2352 by 1568 pixels.
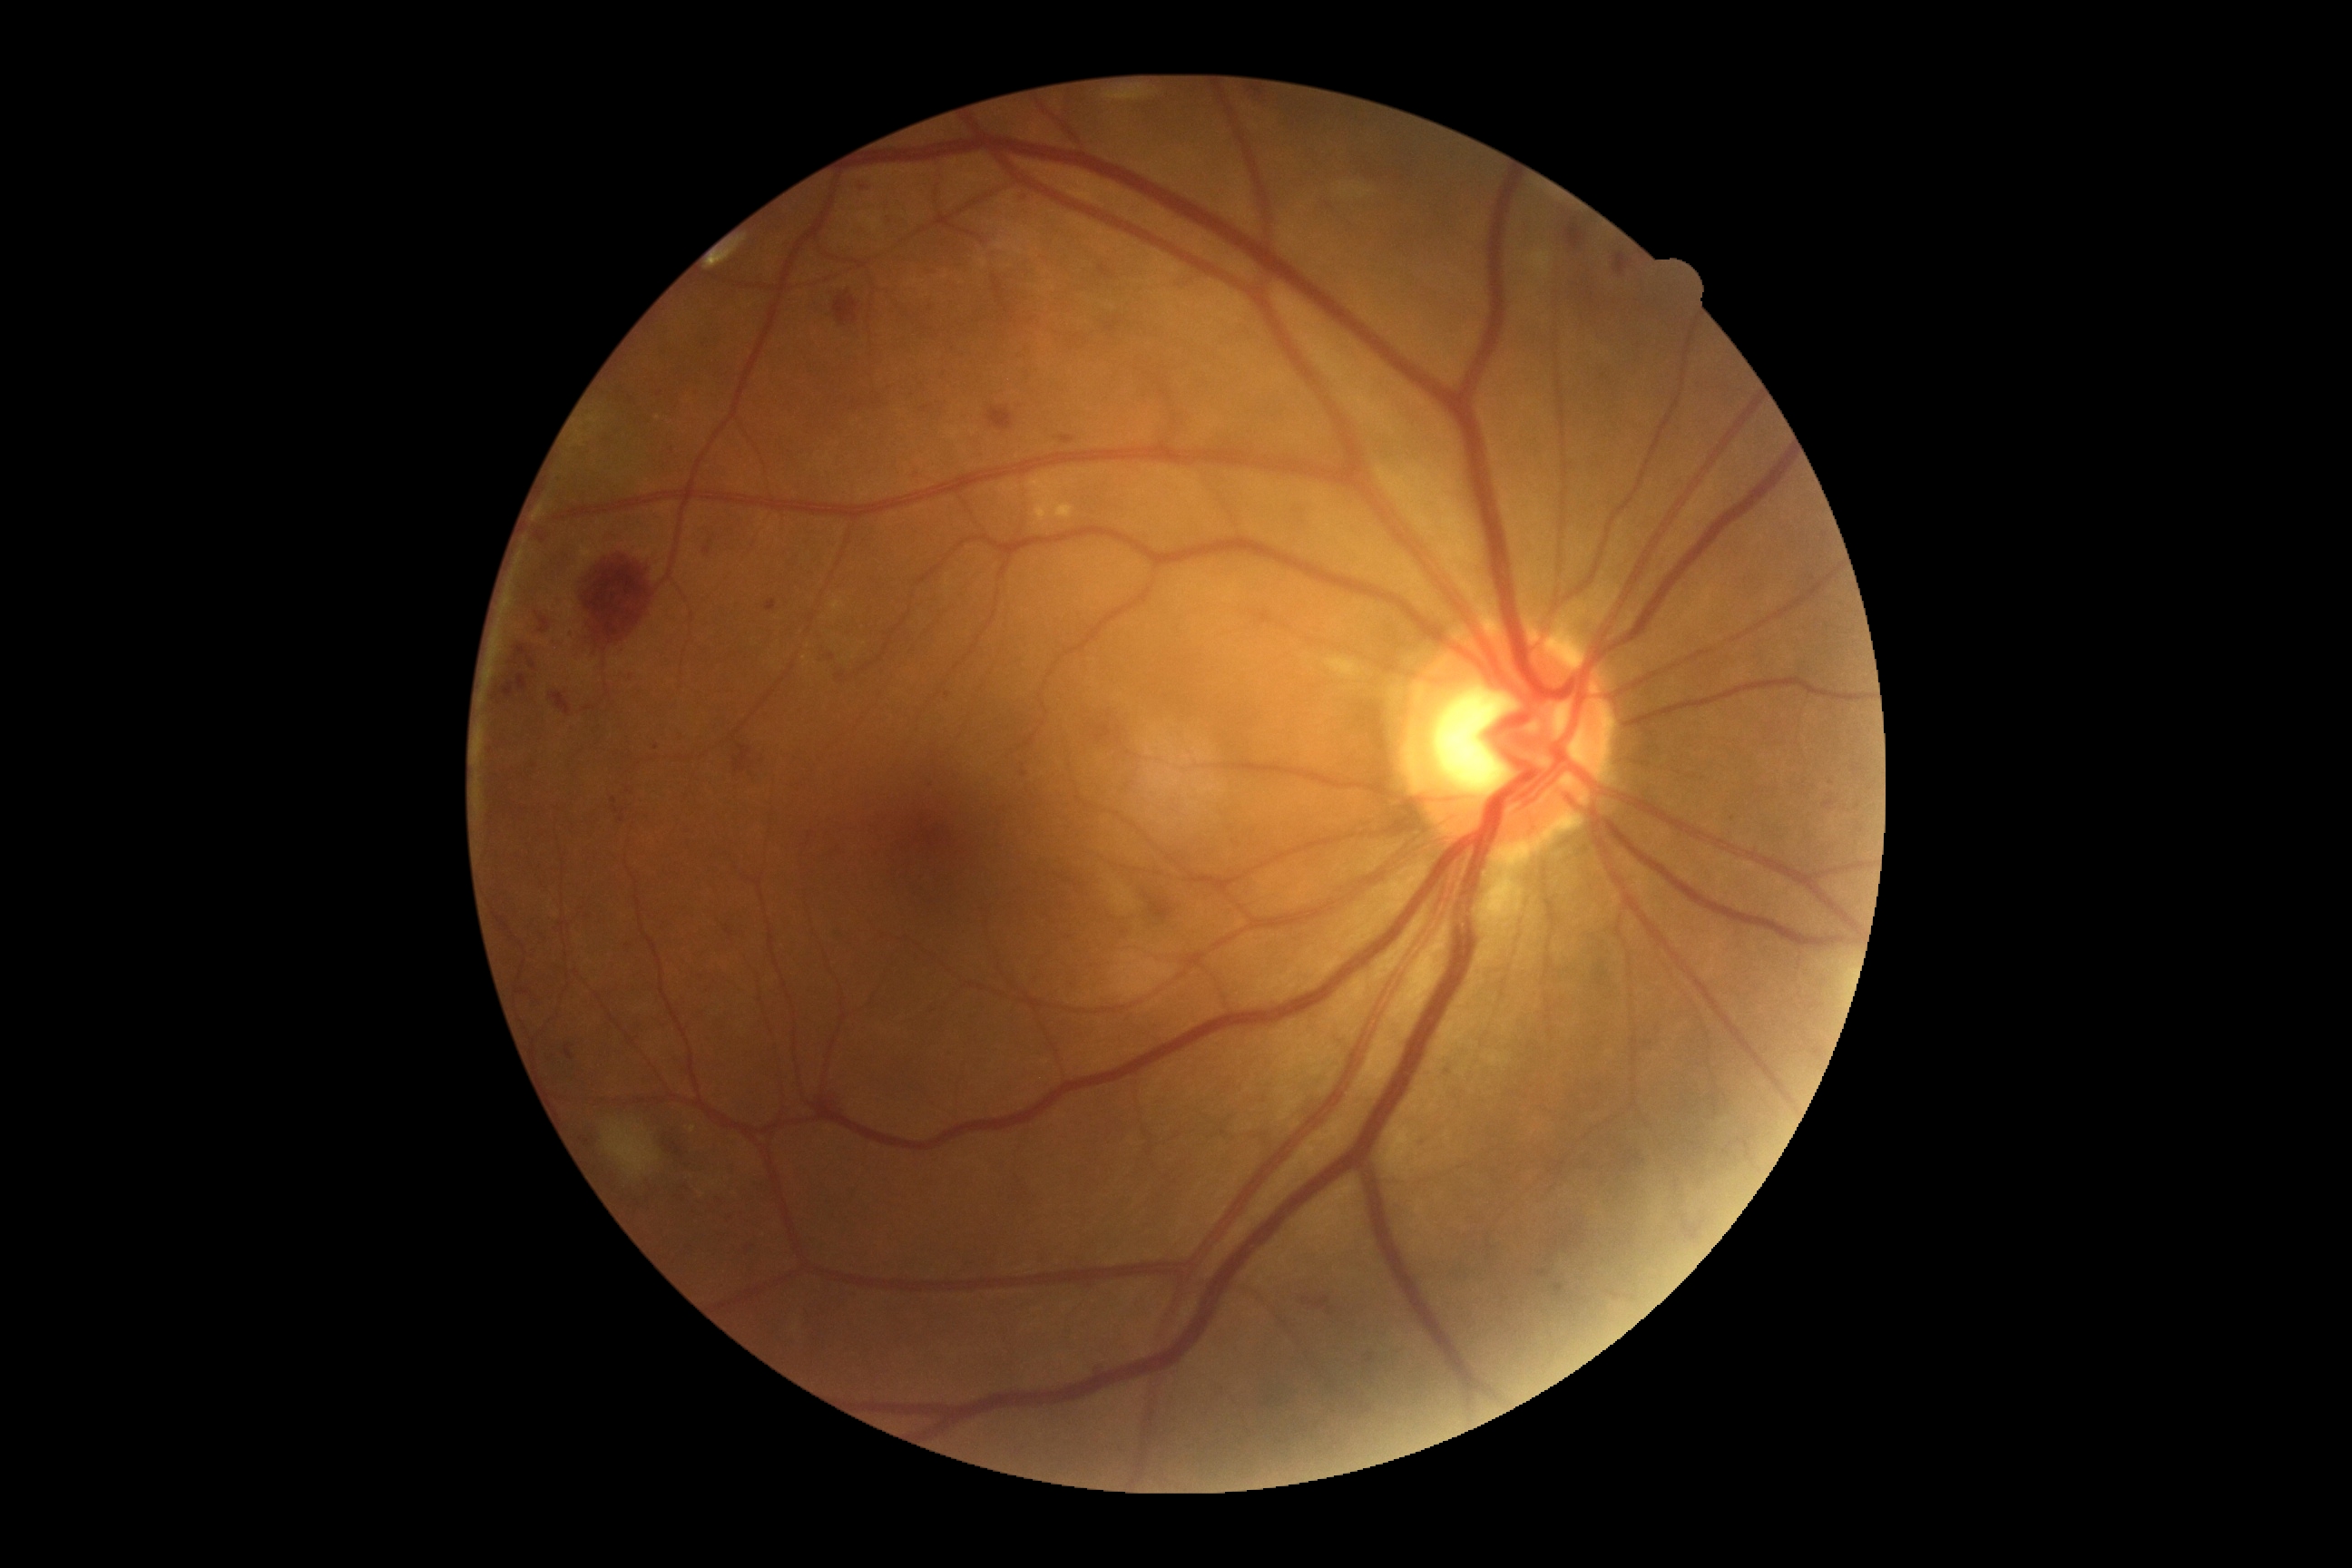
– diabetic retinopathy (DR) — moderate NPDR (grade 2)